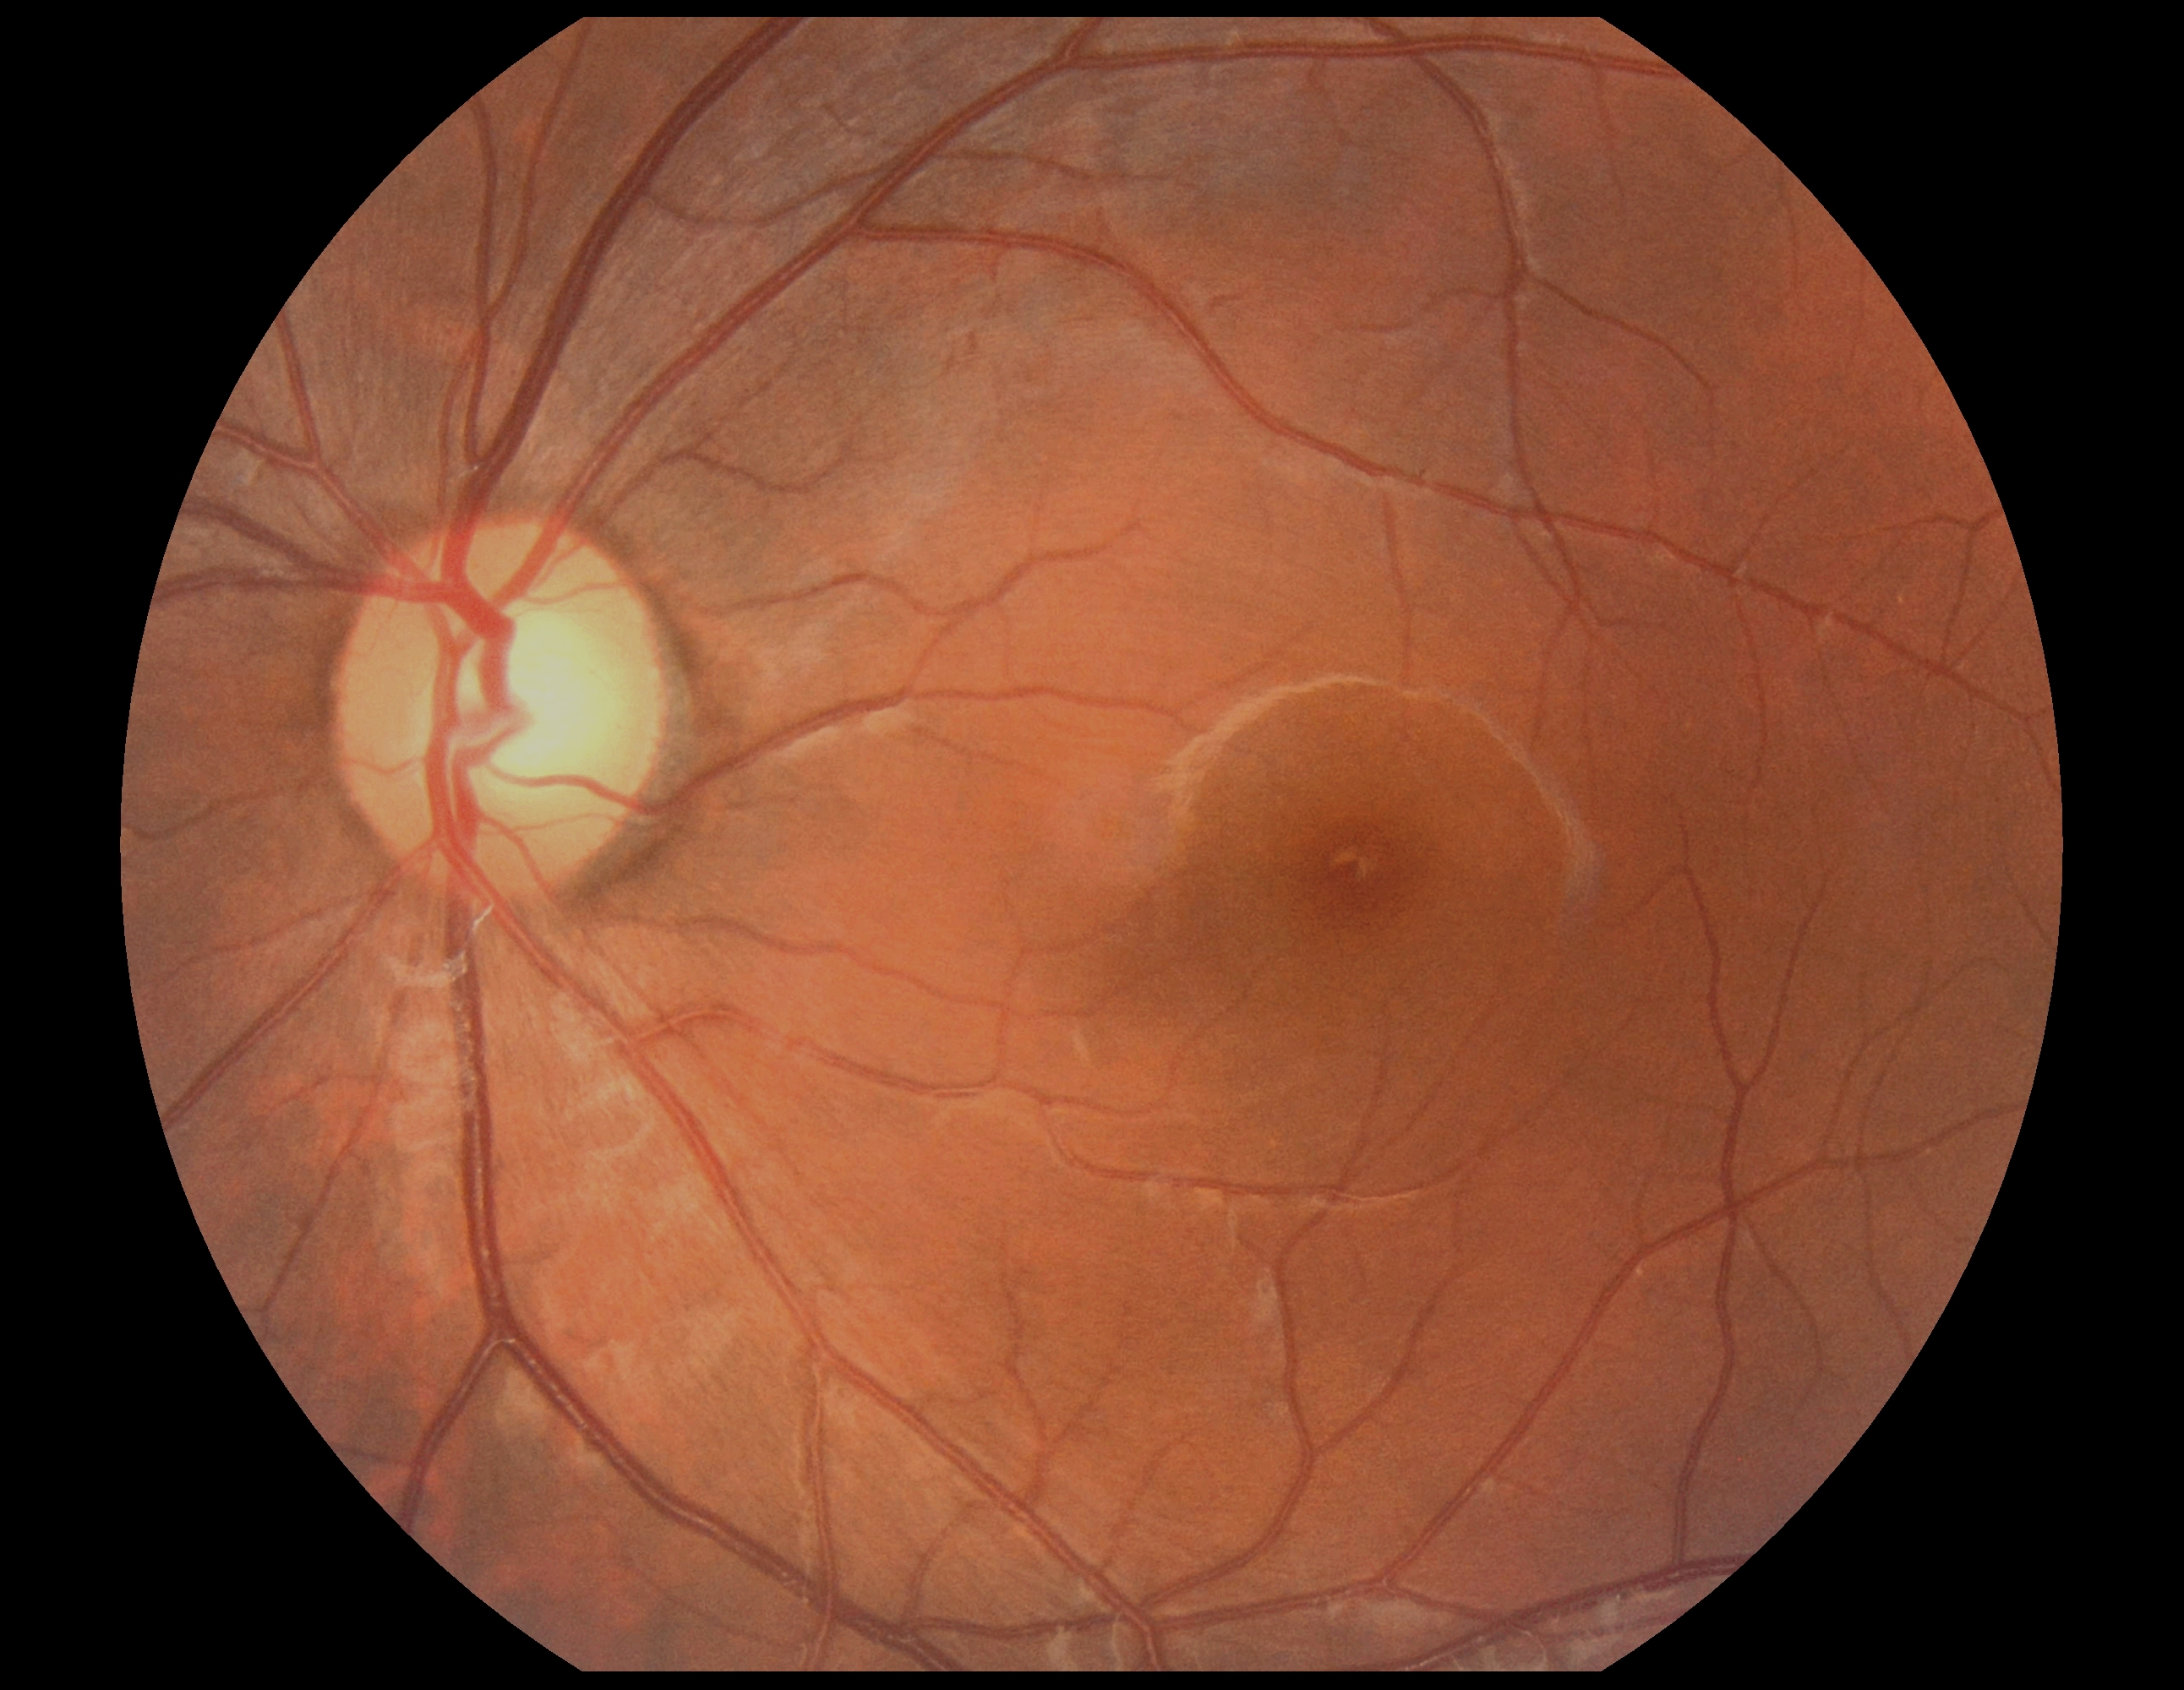
No apparent diabetic retinopathy. DR grade: 0/4.